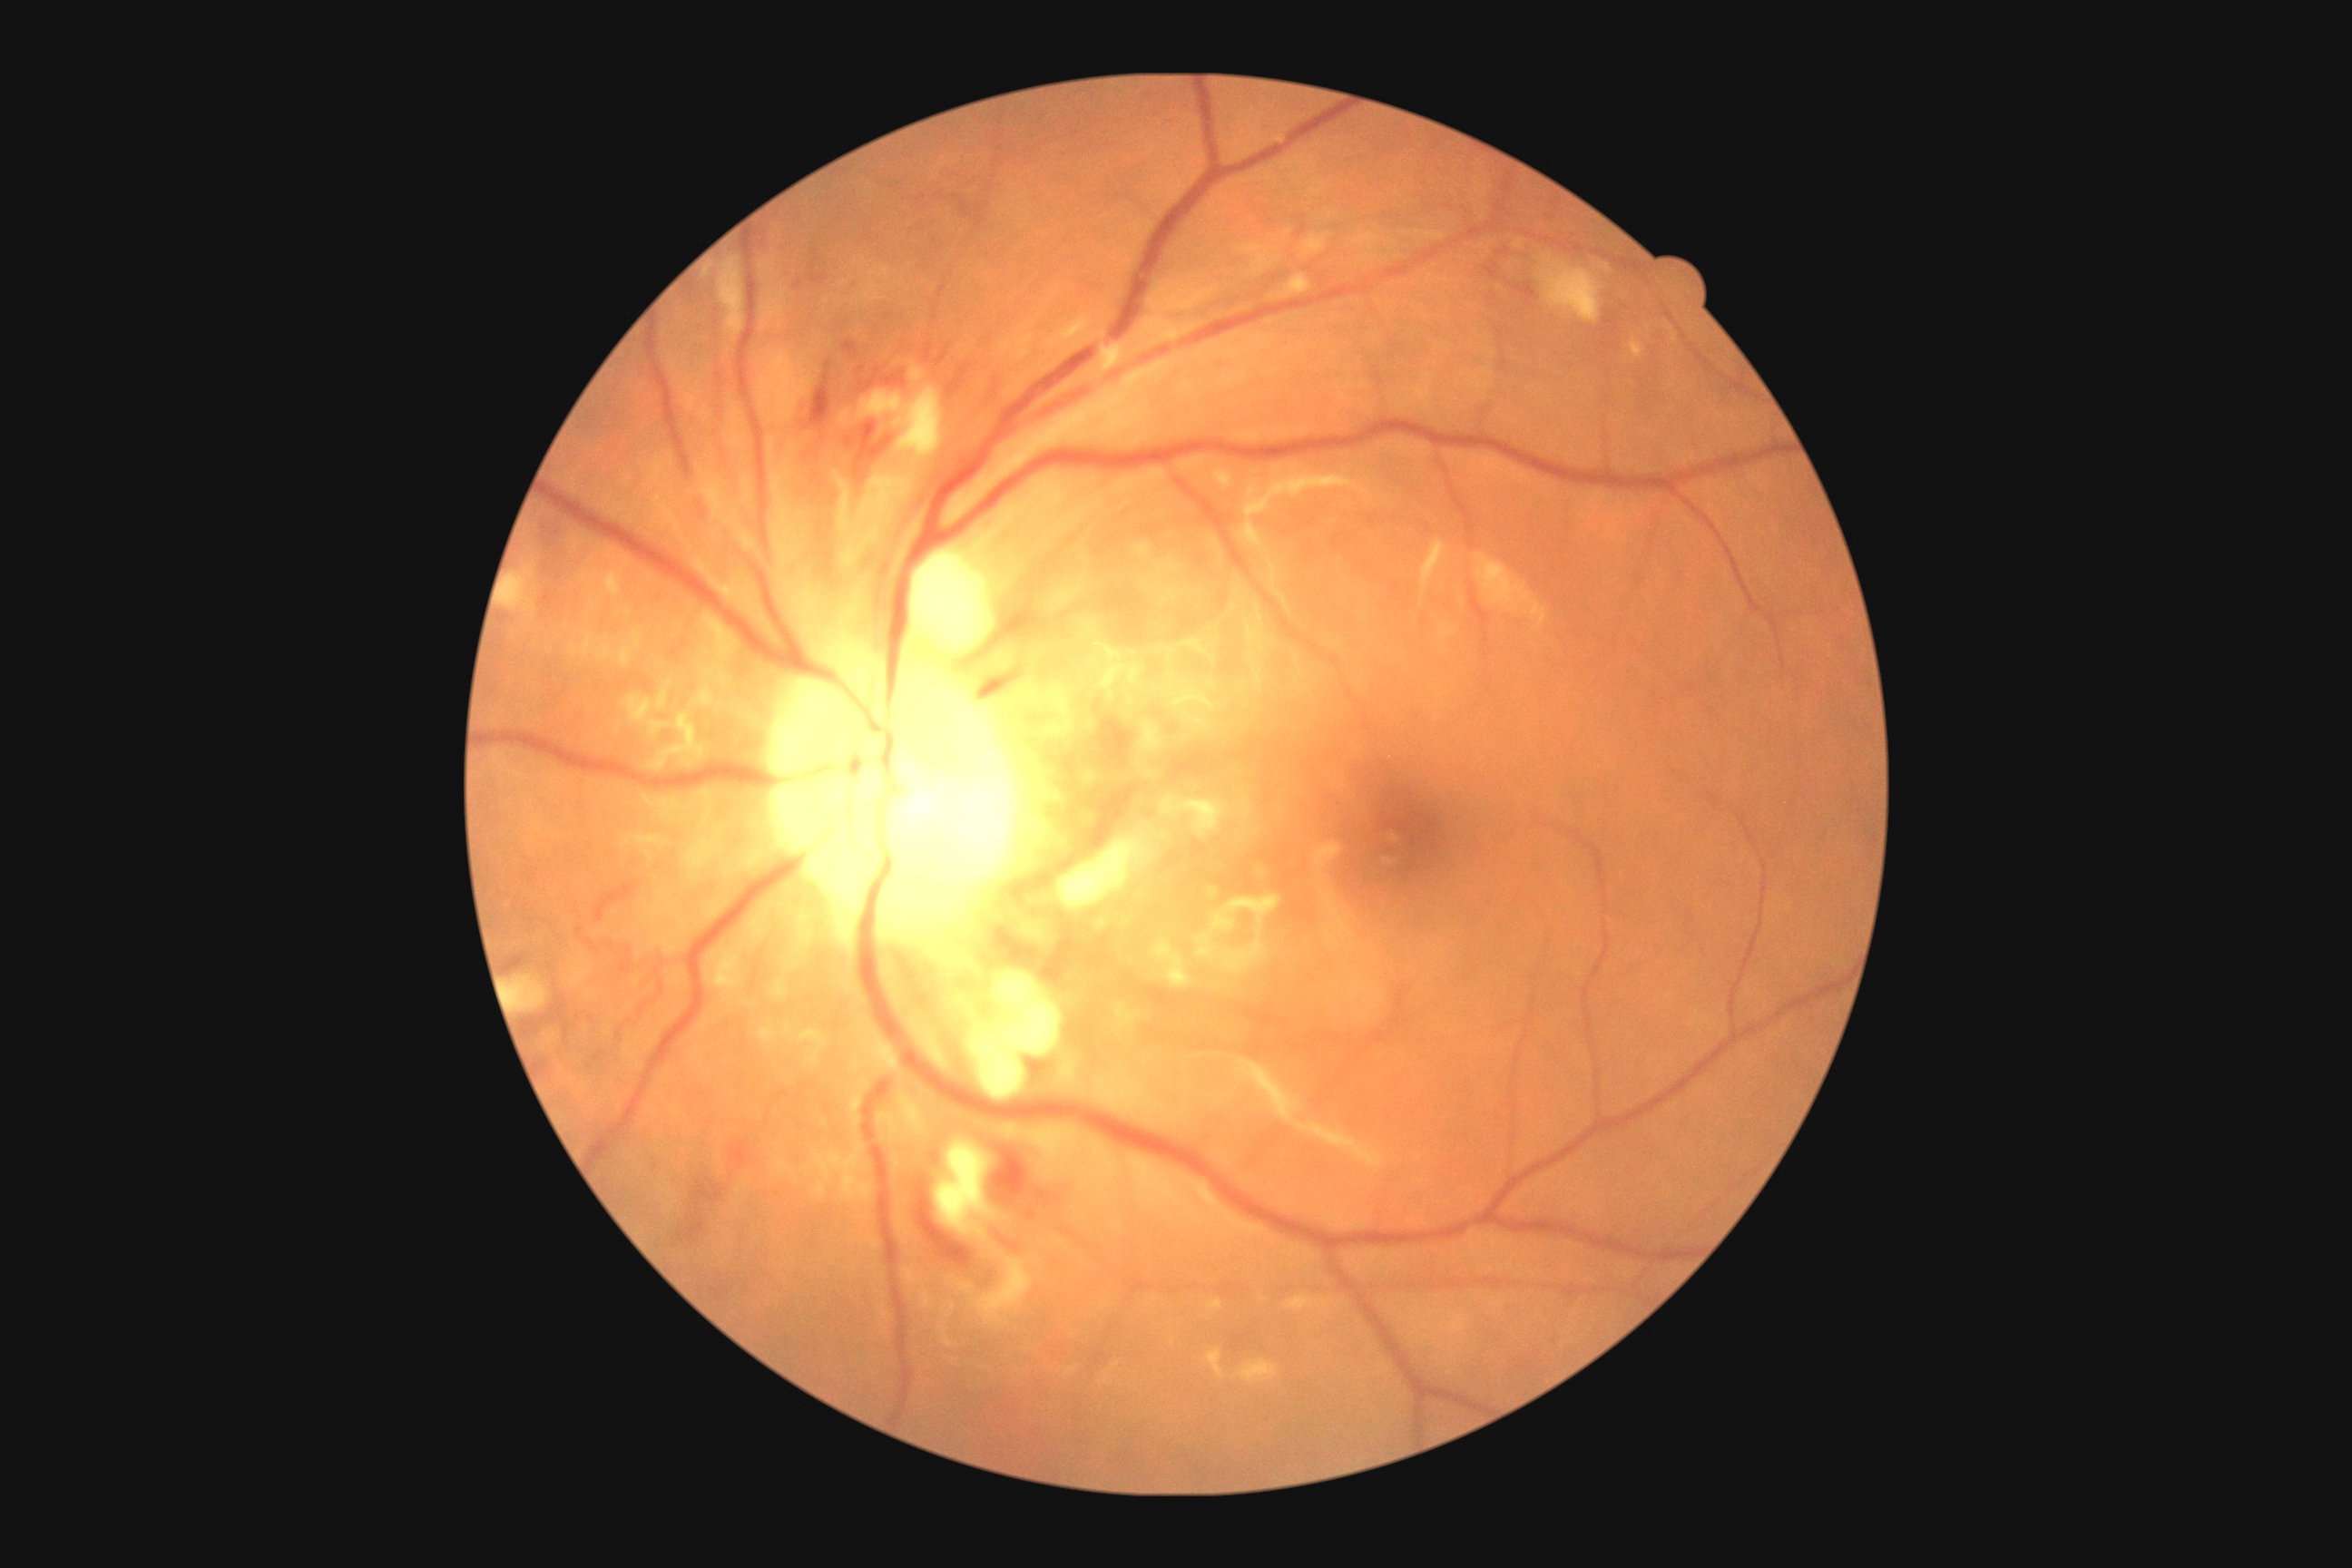
  dr_grade: grade 2 (moderate NPDR)
  dr_category: non-proliferative diabetic retinopathy